Camera: NIDEK AFC-230 — 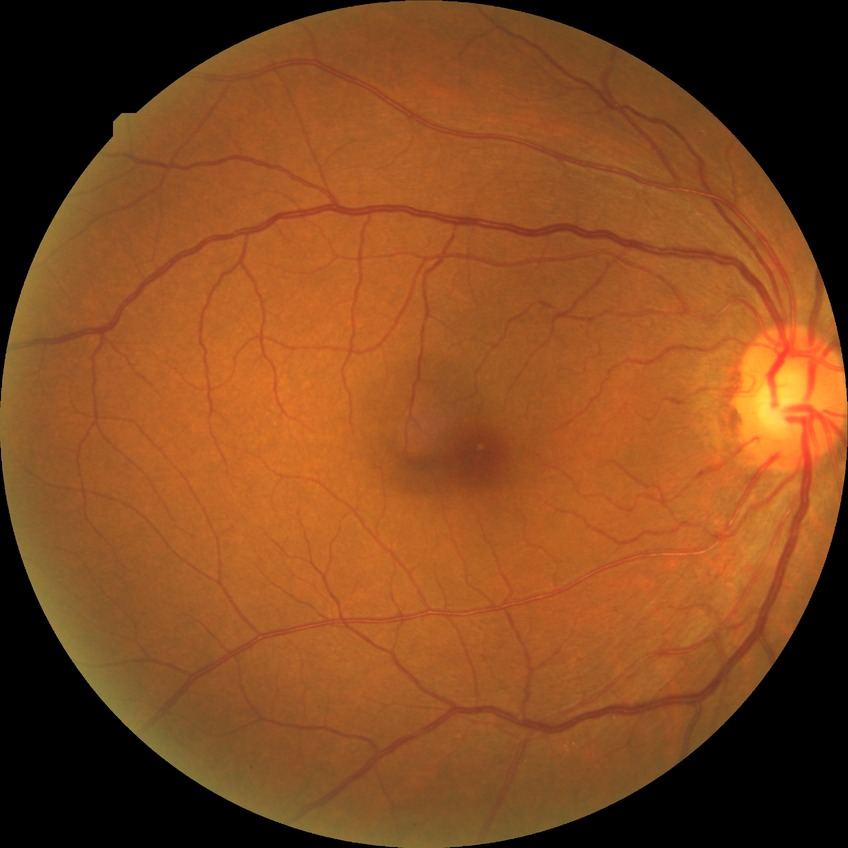

modified Davis grade=NDR; DR impression=no DR findings.